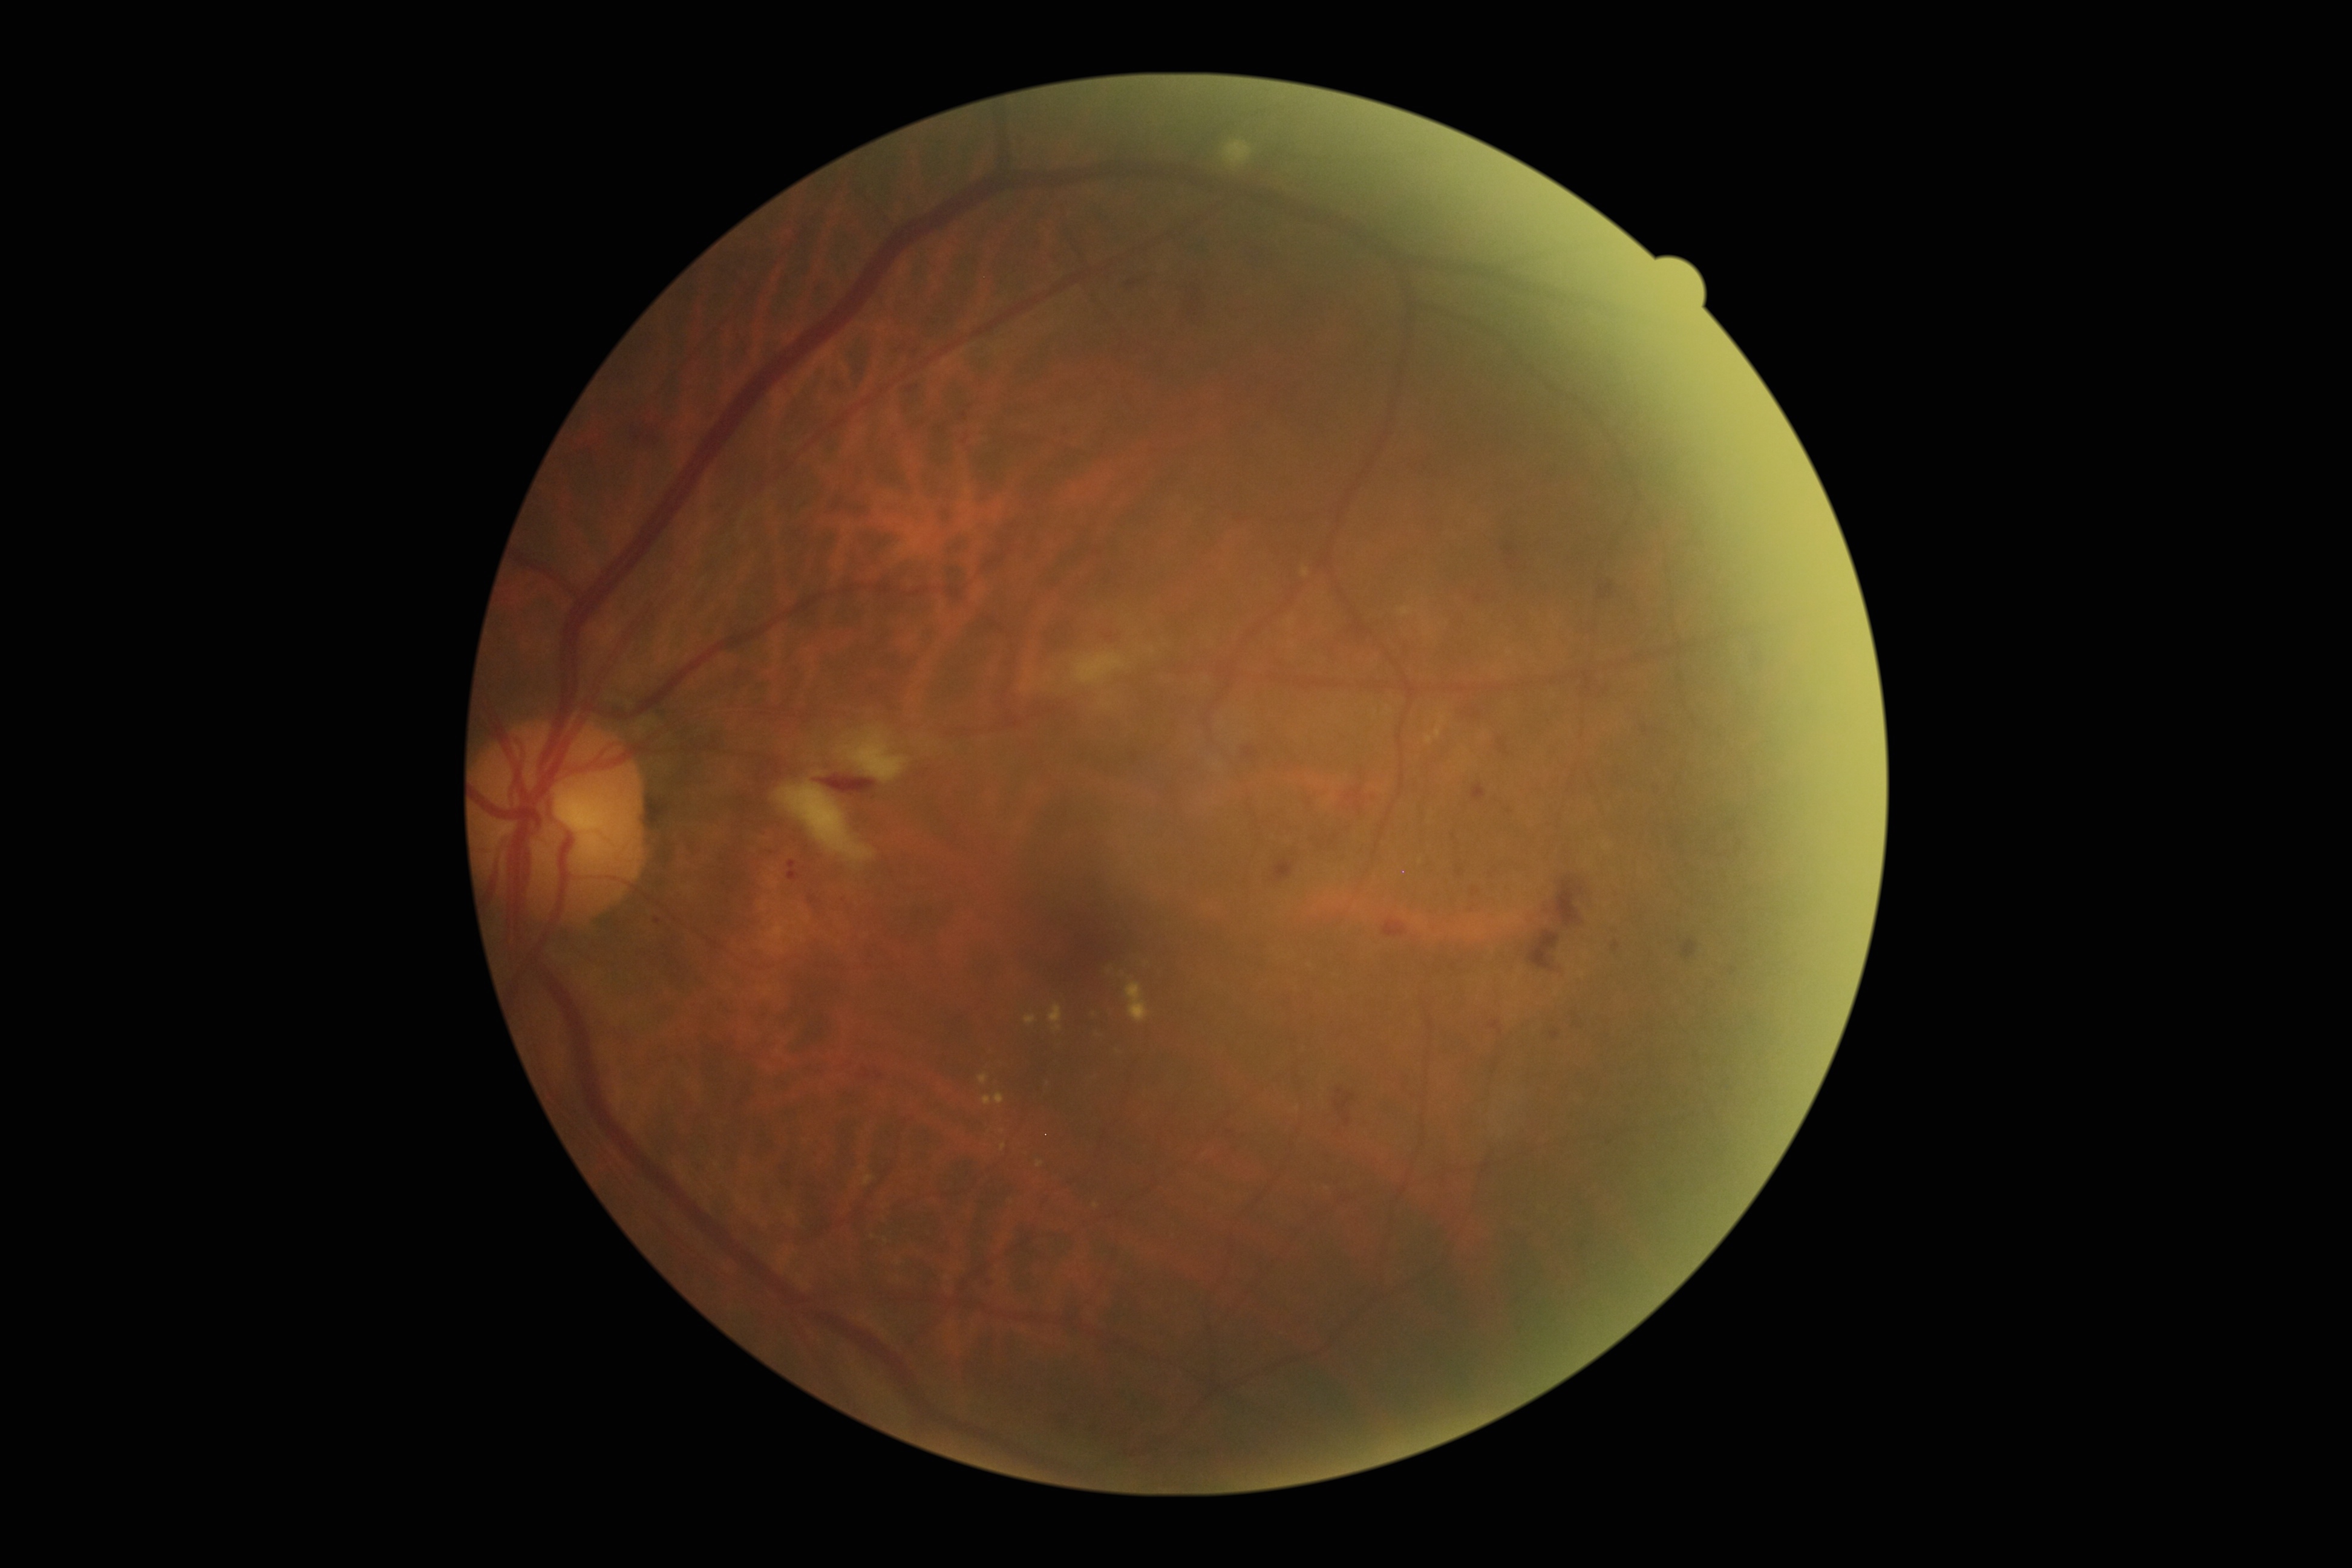
Diabetic retinopathy grade is moderate NPDR (2).